Macula-centered field: 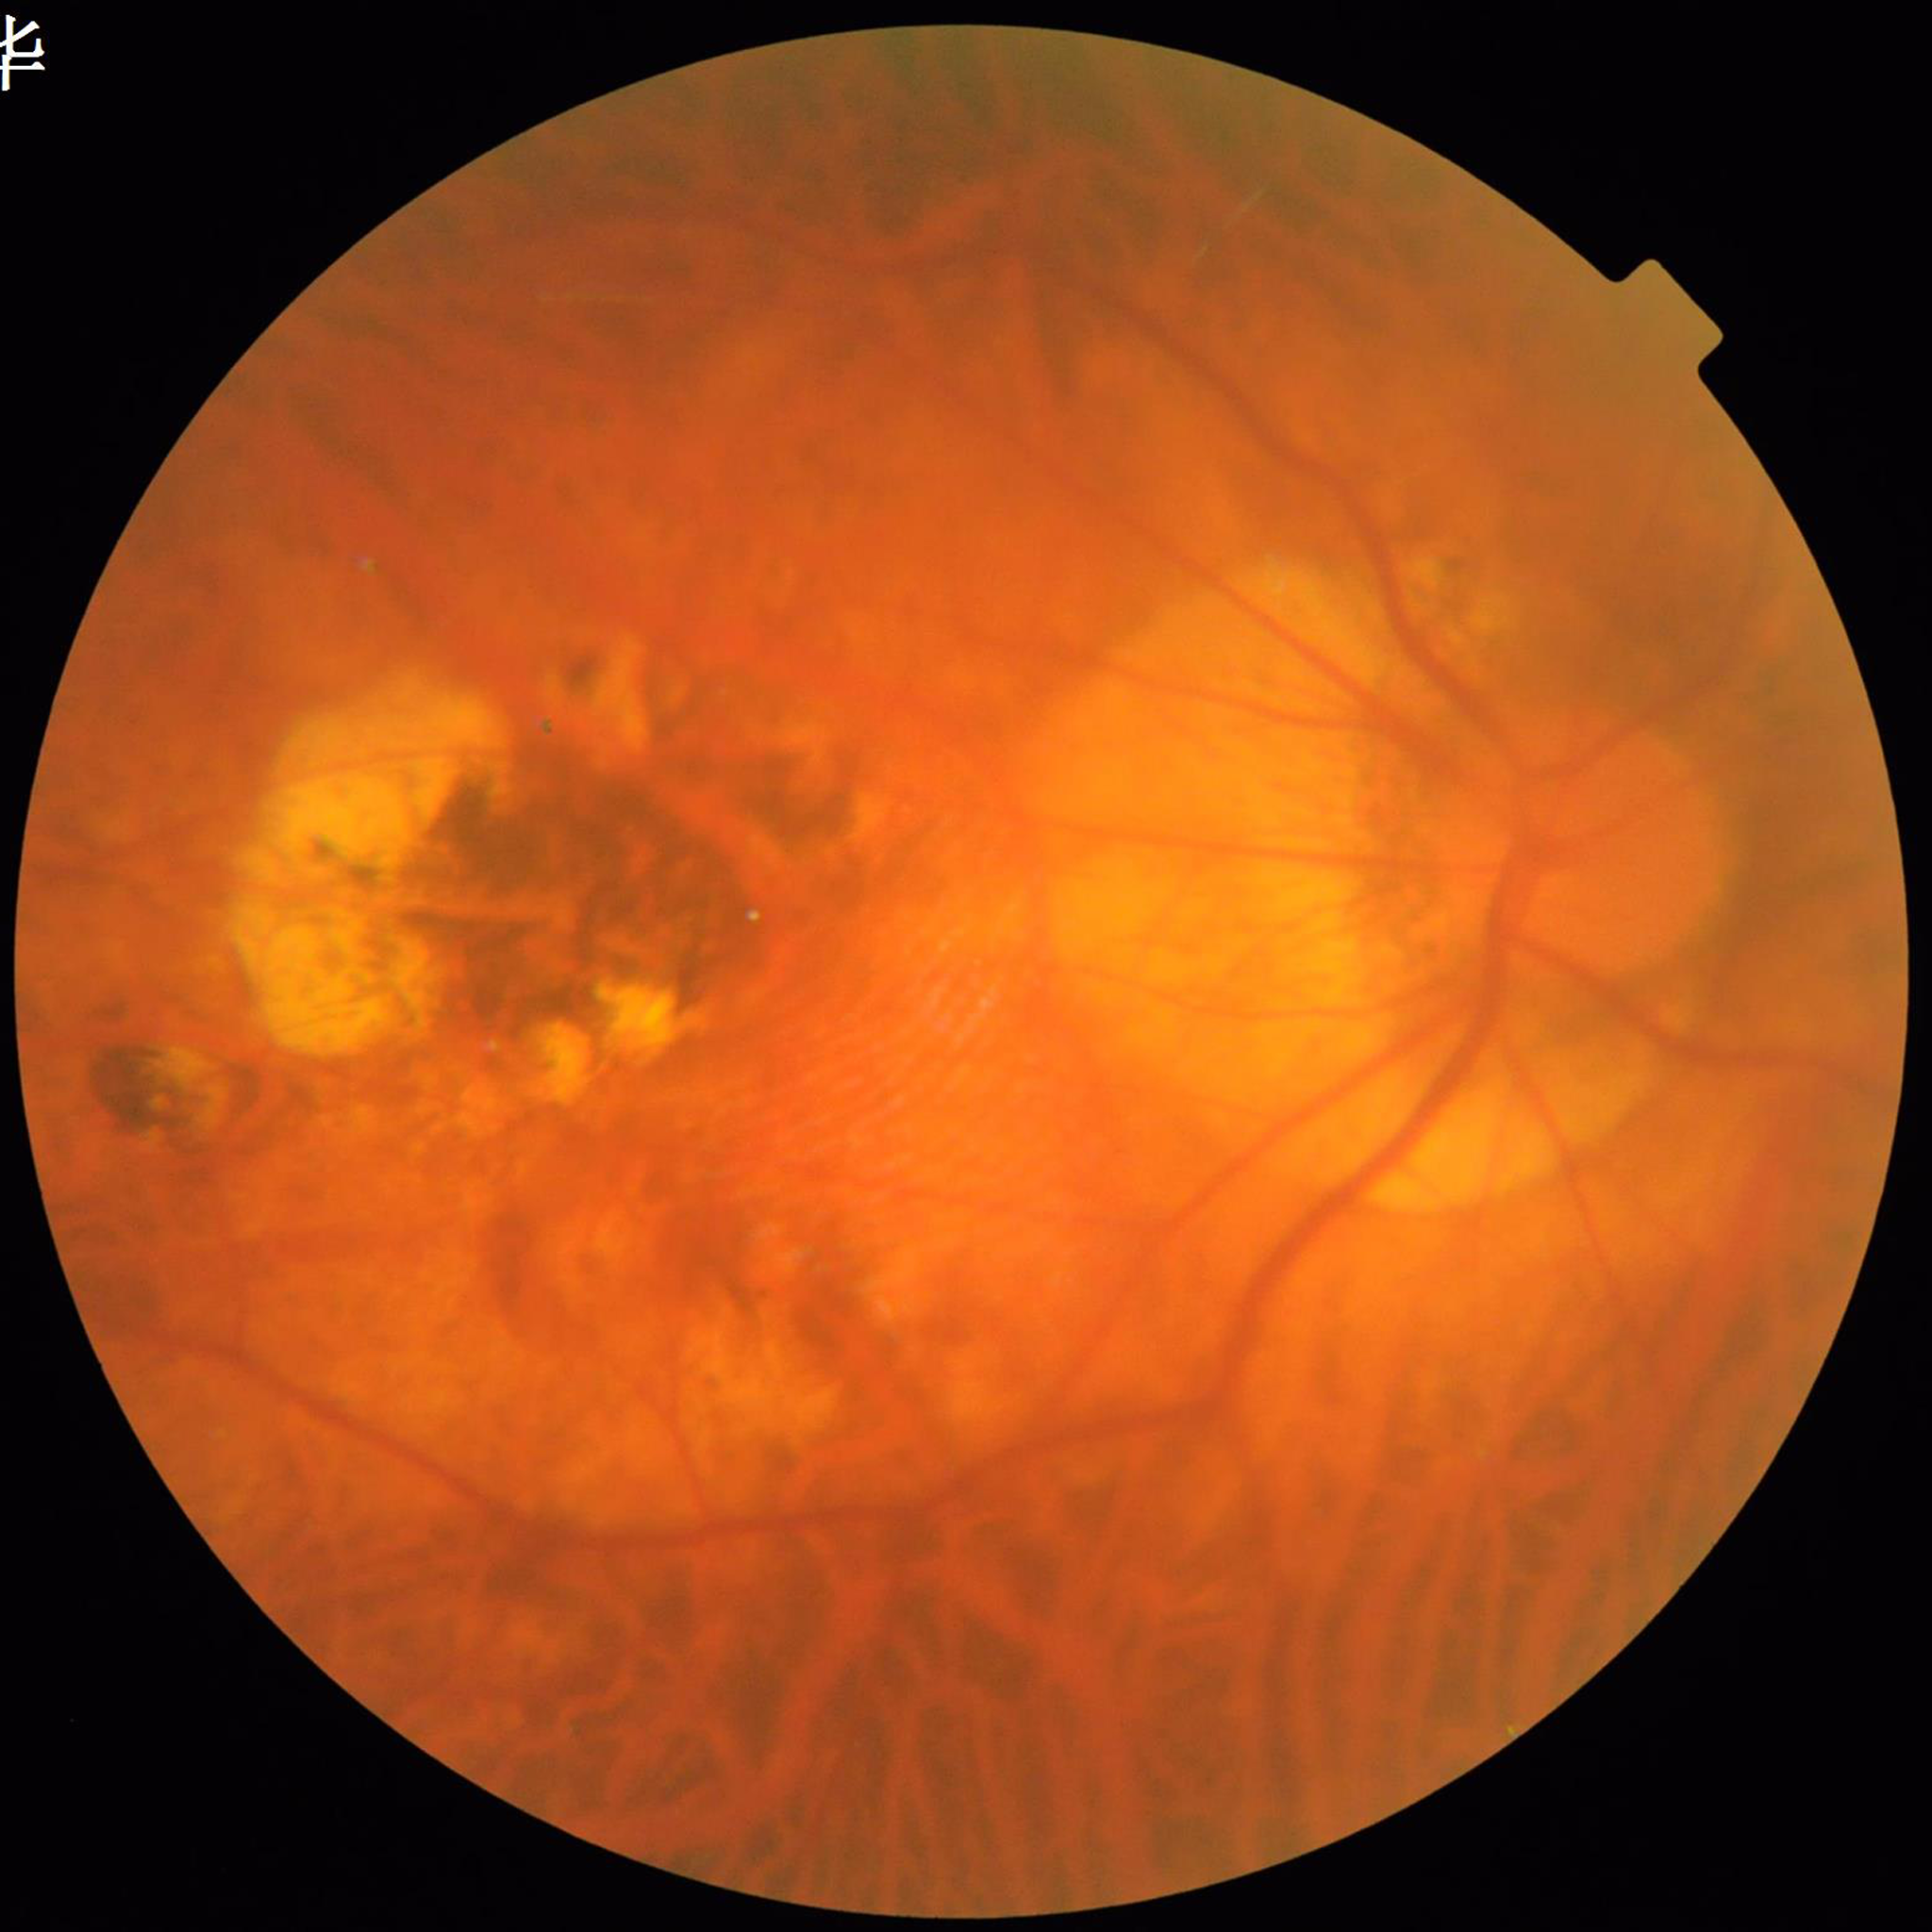
Color fundus photograph from a patient diagnosed with AMD.